FOV: 45 degrees.
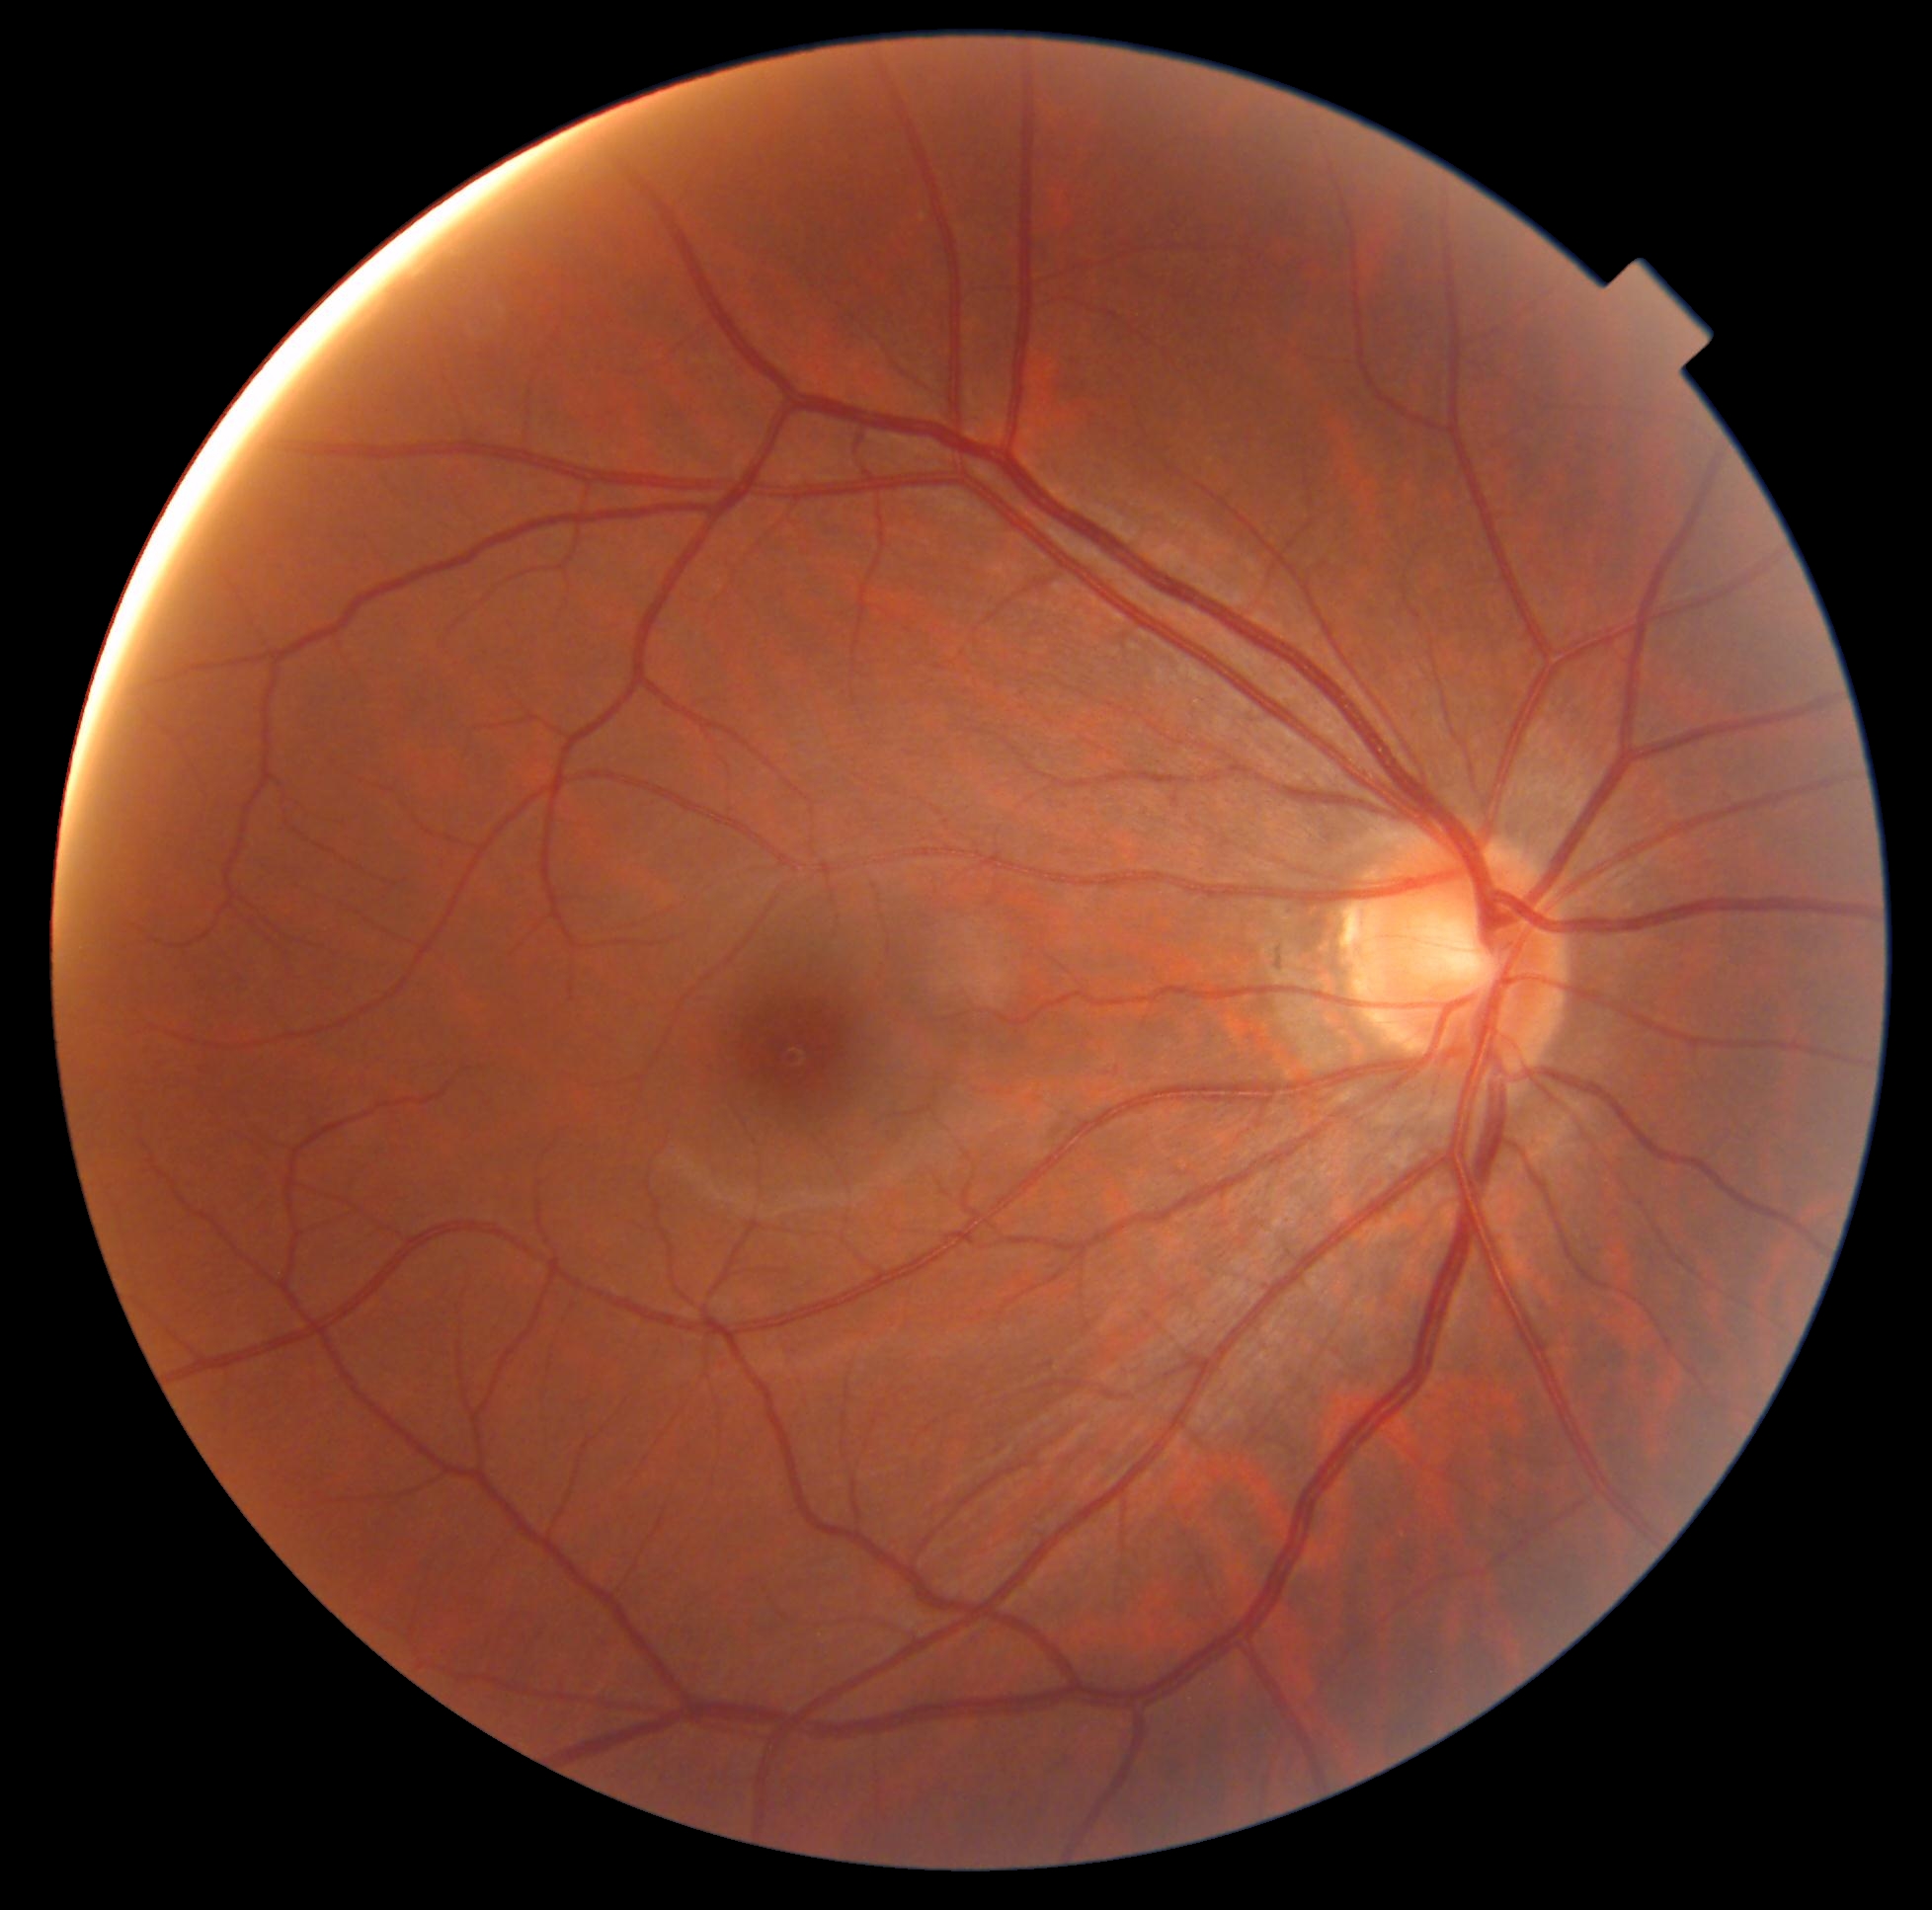 * DR severity — 0